1924 x 1556 pixels; 200° field of view; UWF retinal mosaic.
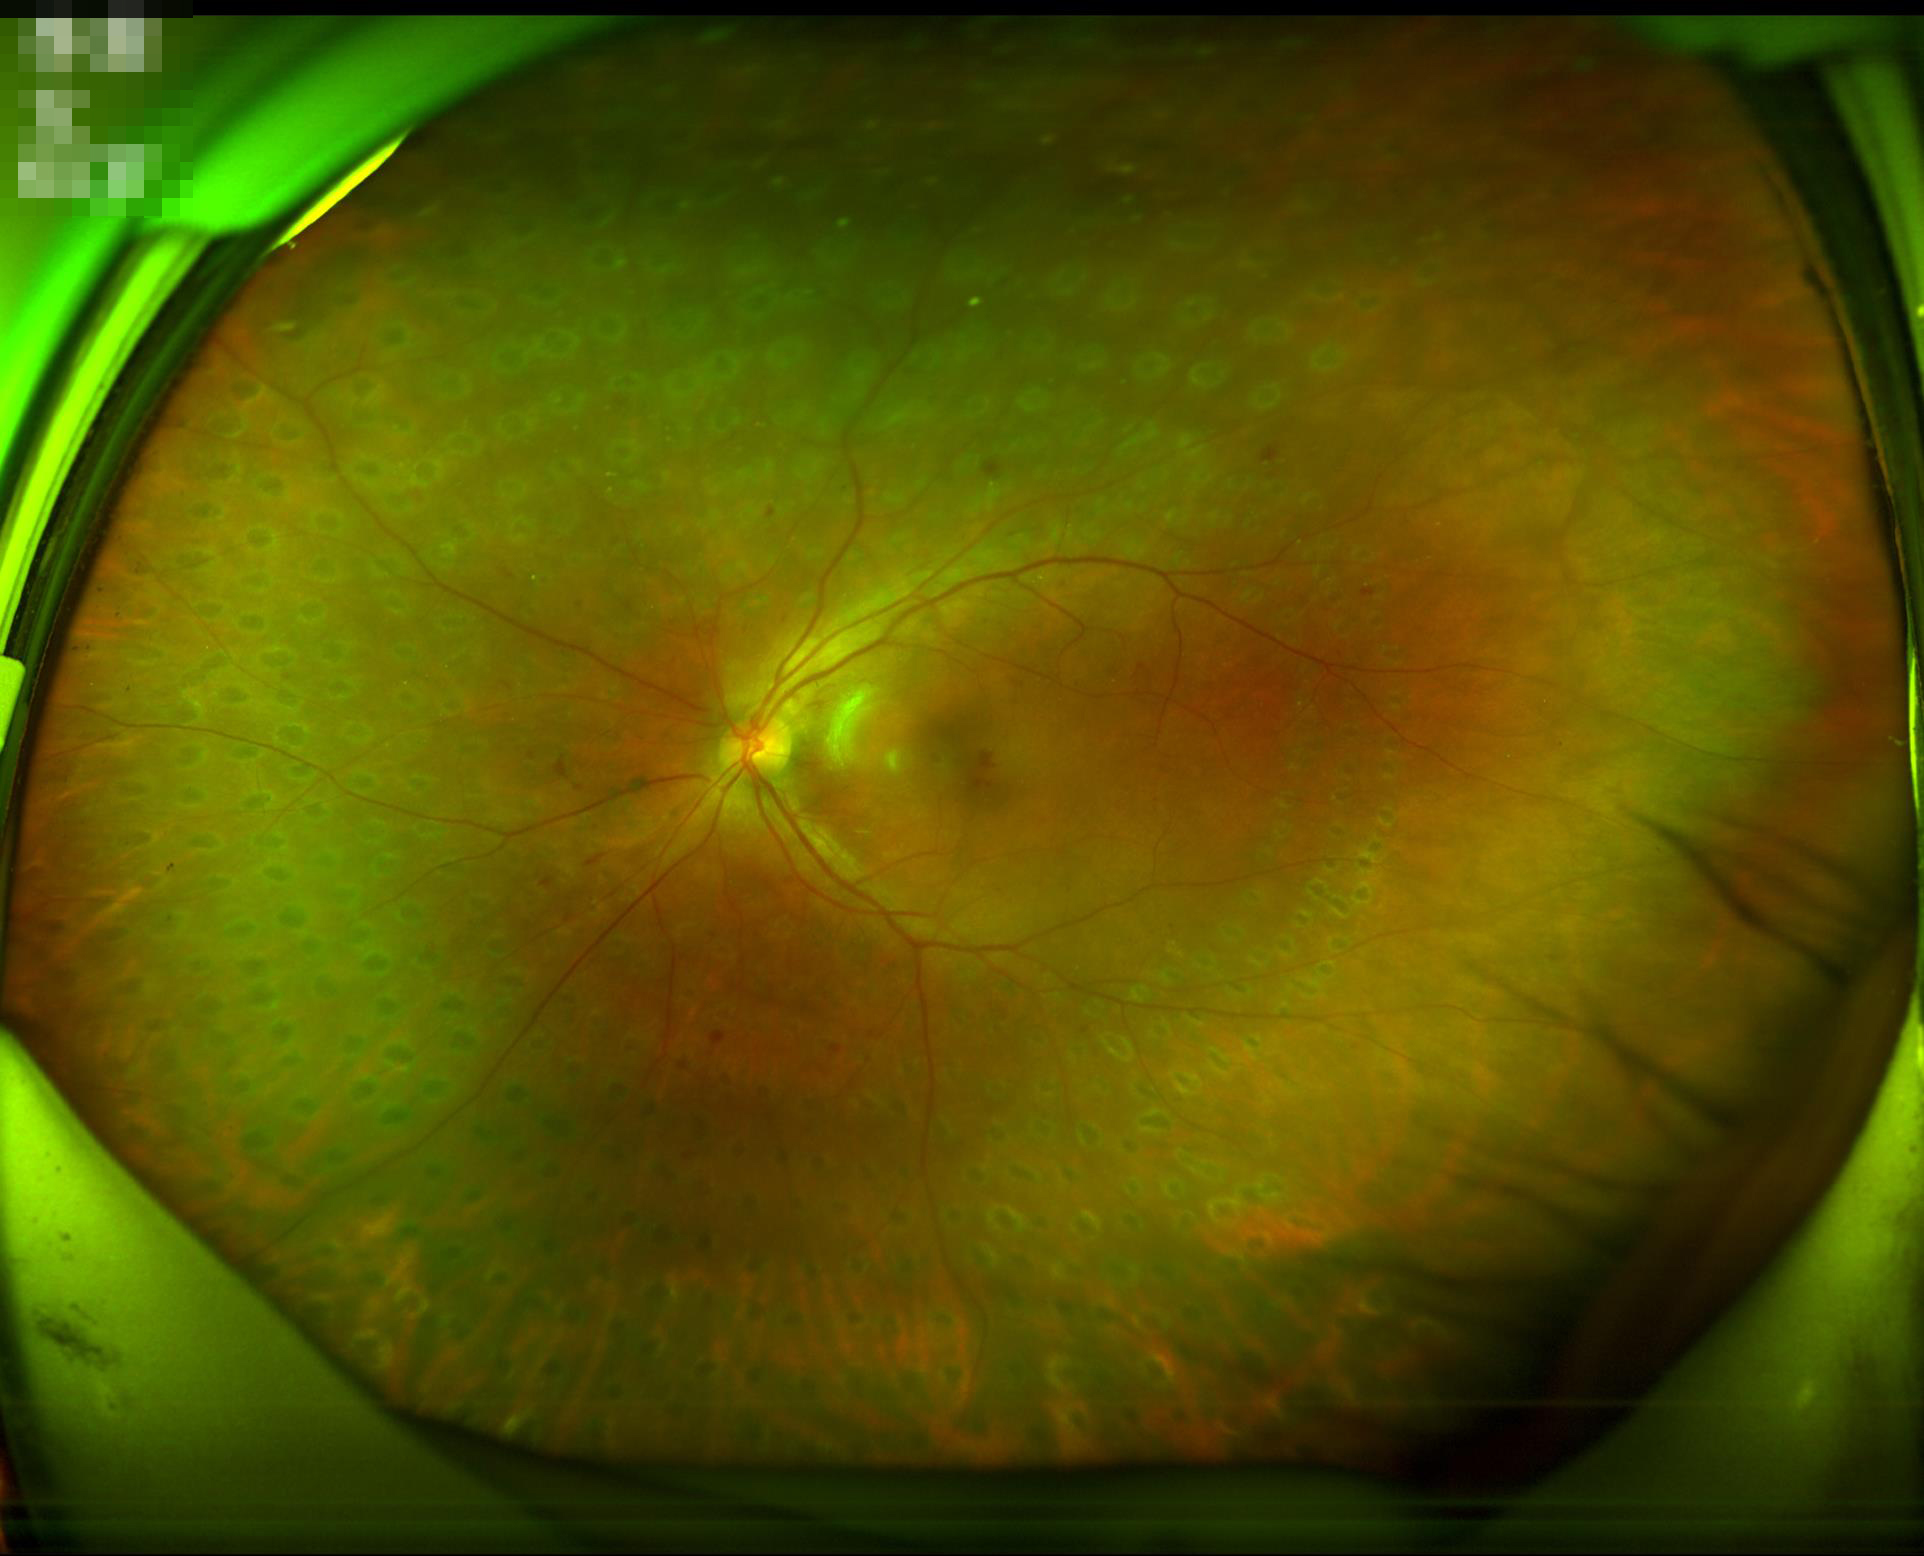 Image quality is adequate for diagnostic use. Image is sharp throughout the field. No over- or under-exposure.